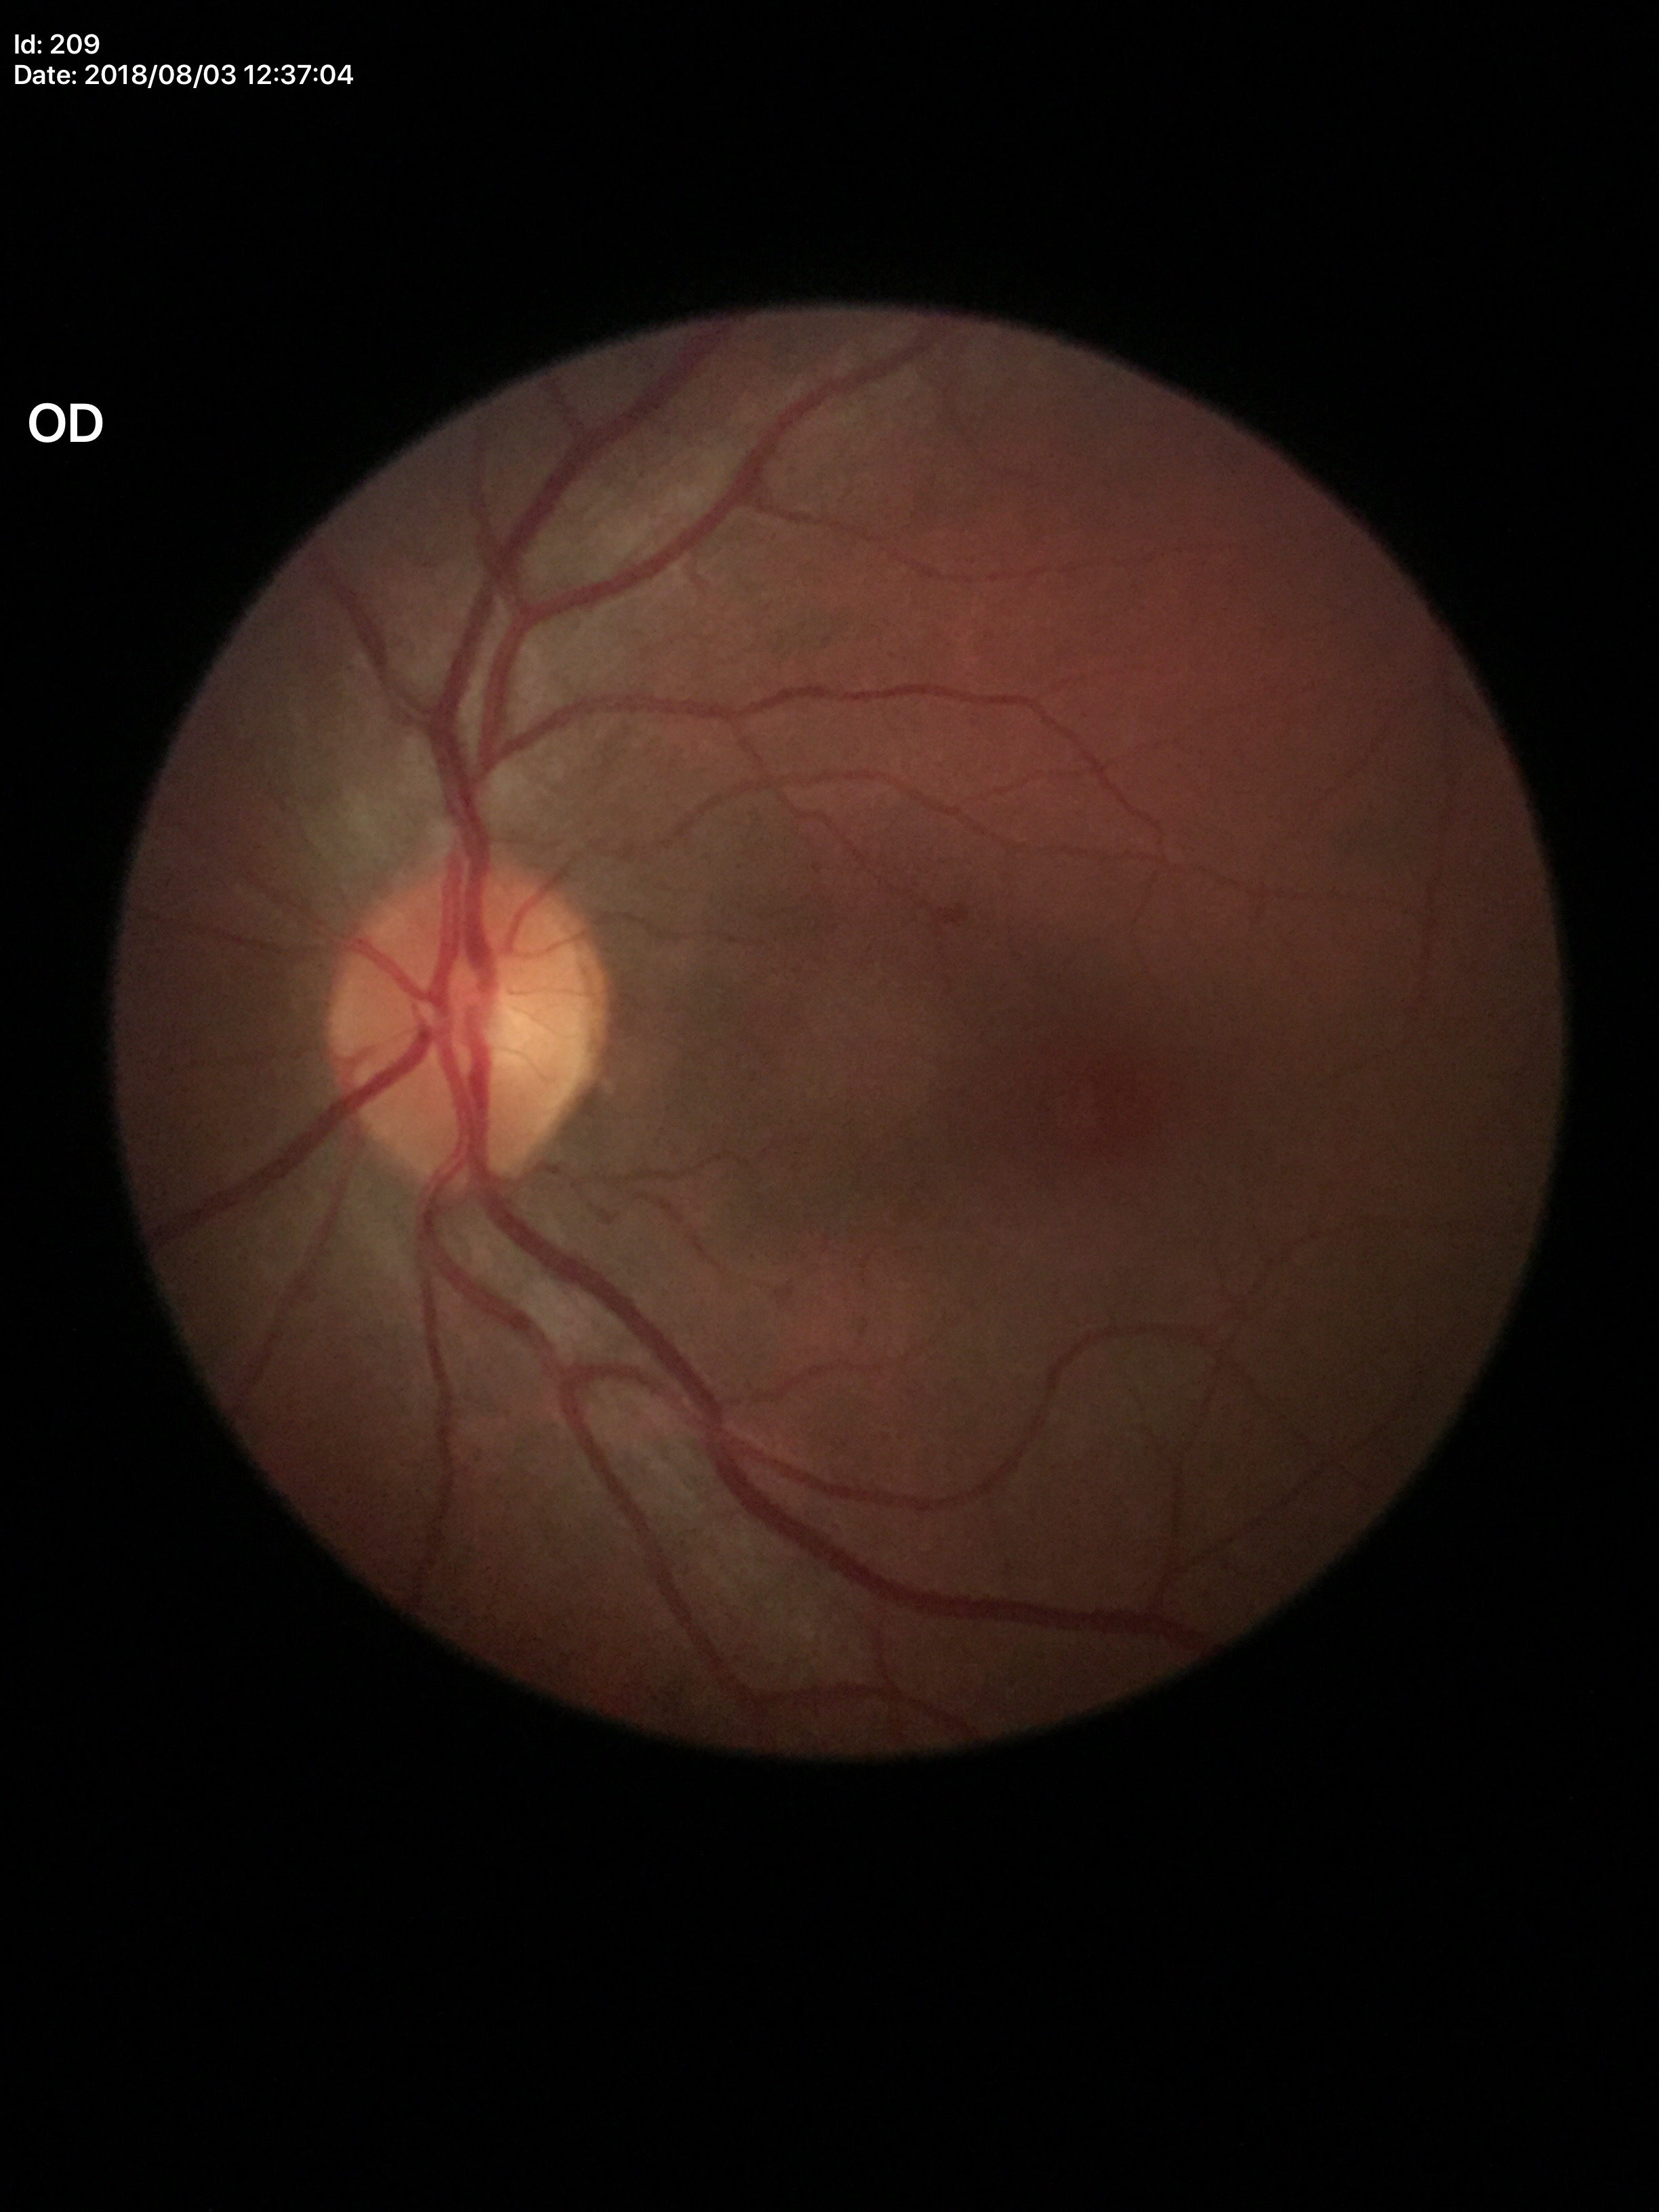 Glaucoma screening impression: negative, vertical cup-to-disc ratio (VCDR): 0.47, horizontal C/D ratio (HCDR): 0.45.